Acquired on the Phoenix ICON · image size 1240x1240 · Phoenix ICON wide-field infant fundus image — 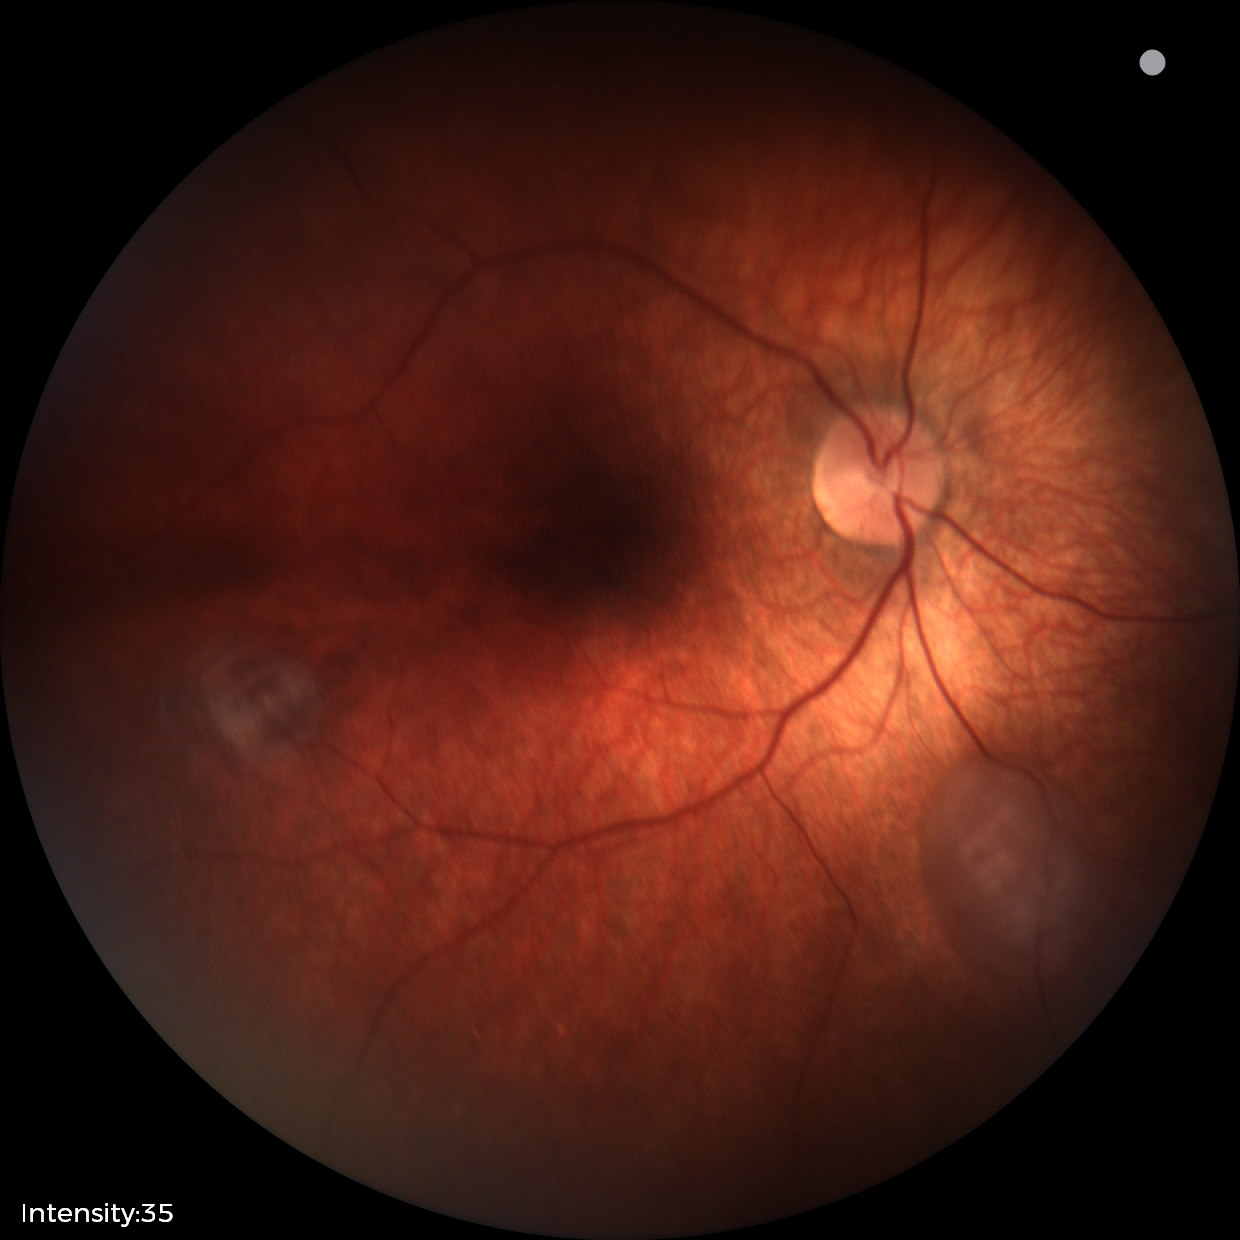
From an examination with diagnosis of retinal astrocytic hamartoma.